NIDEK AFC-230, image size 848x848
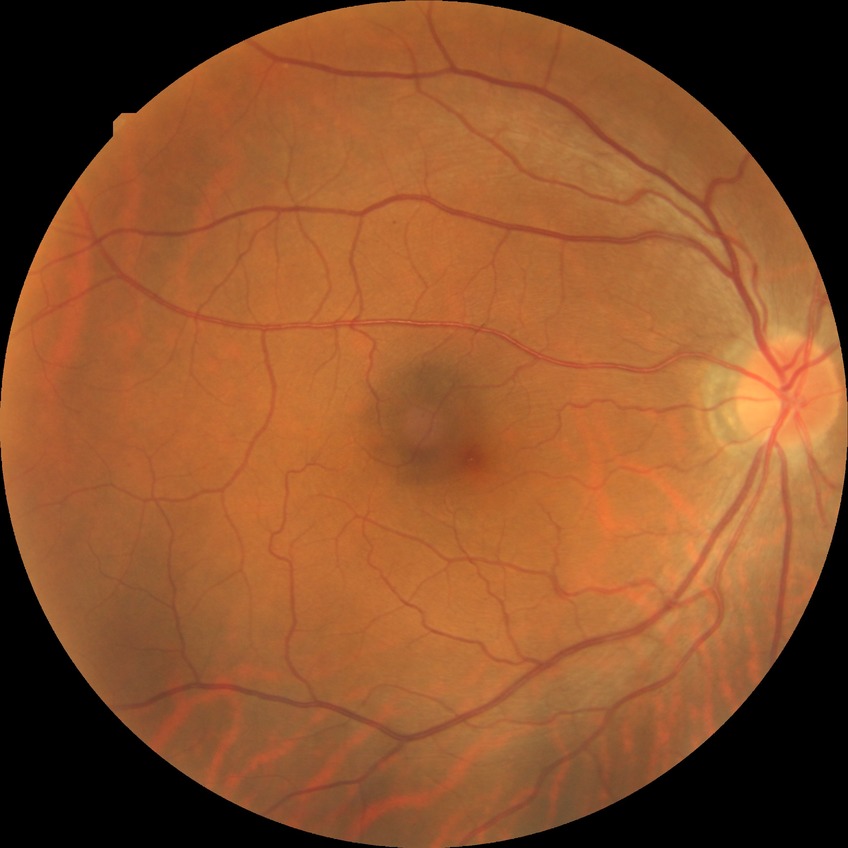 Diabetic retinopathy (DR): no diabetic retinopathy (NDR).